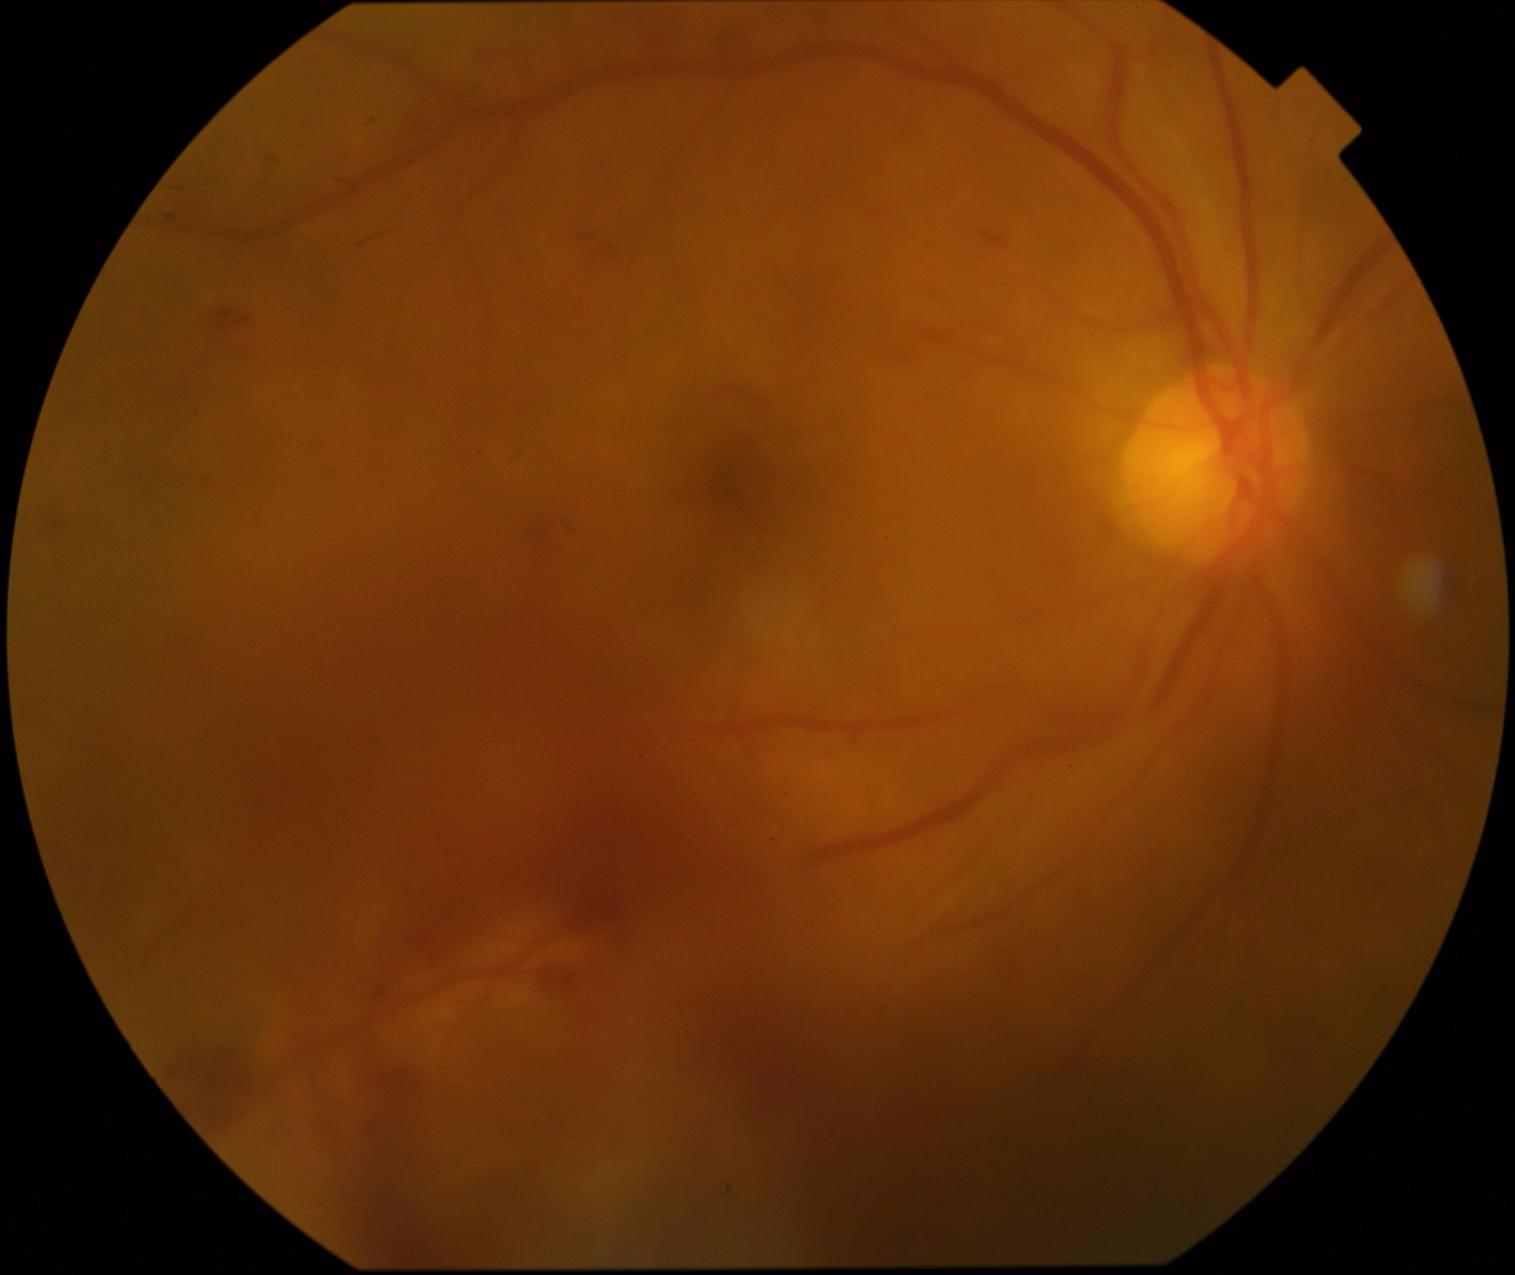

DR grade is 4.